45° FOV: 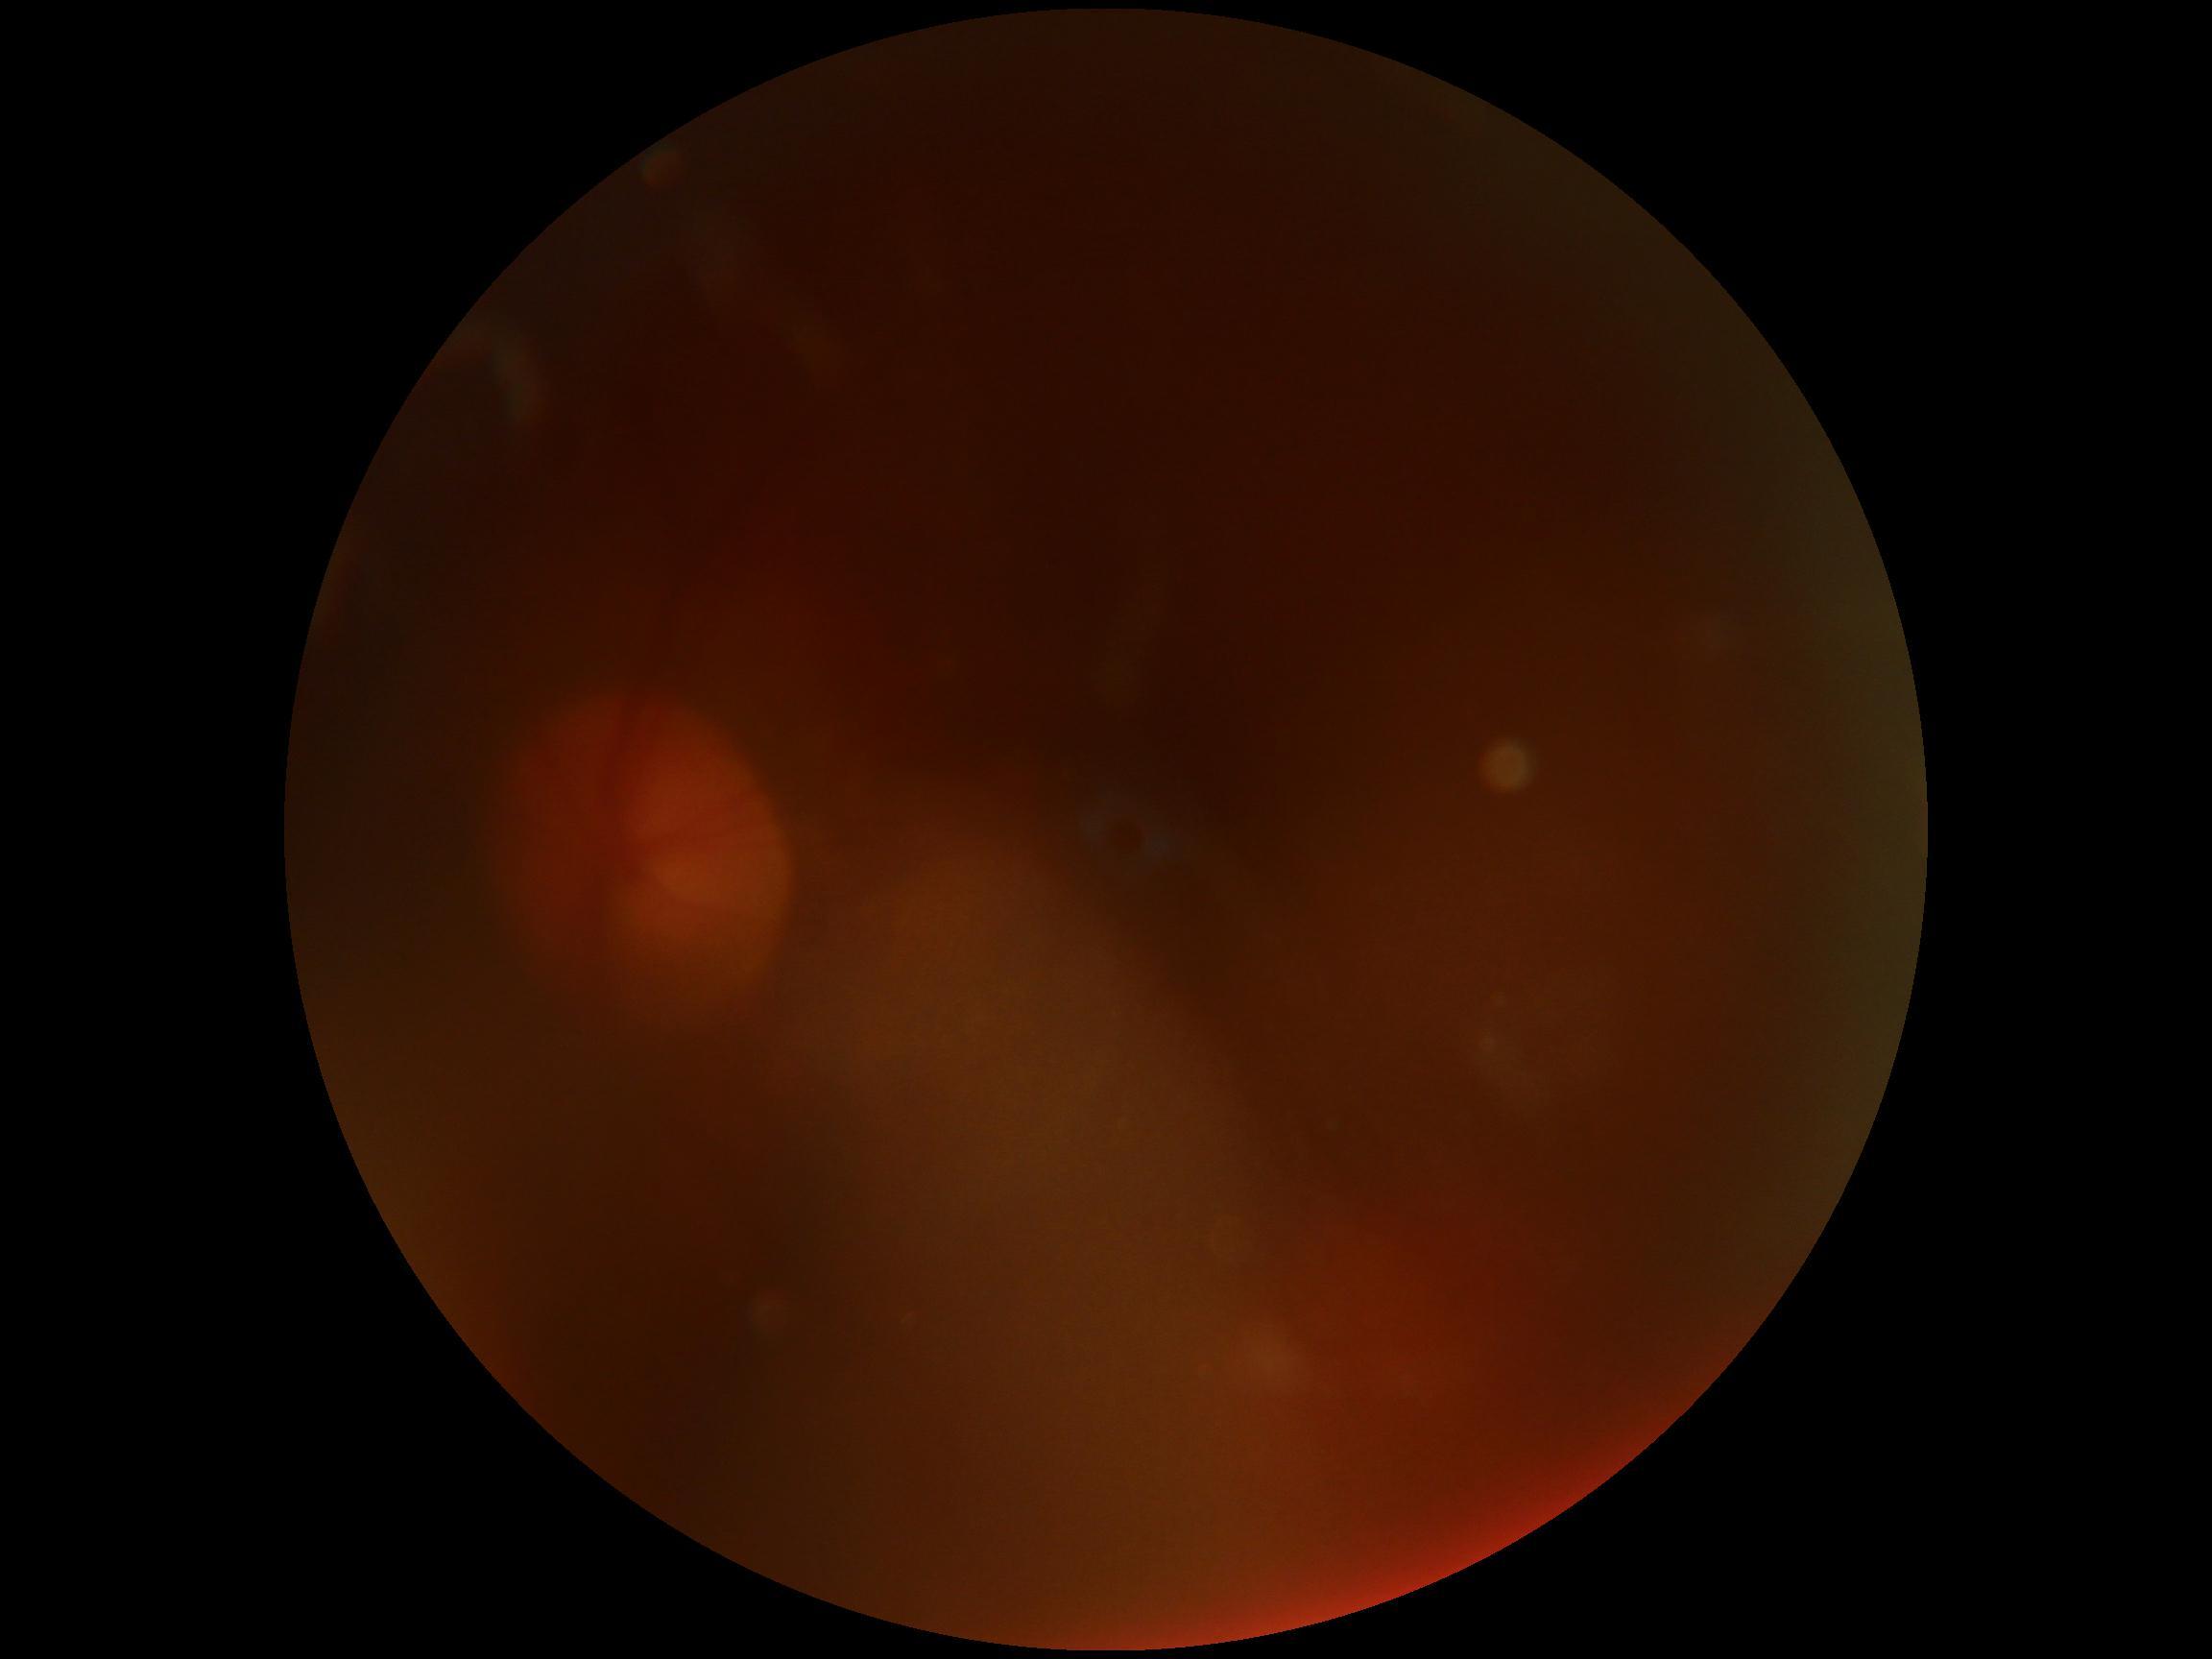

DR severity: ungradable due to poor image quality, image quality: too poor for DR grading.